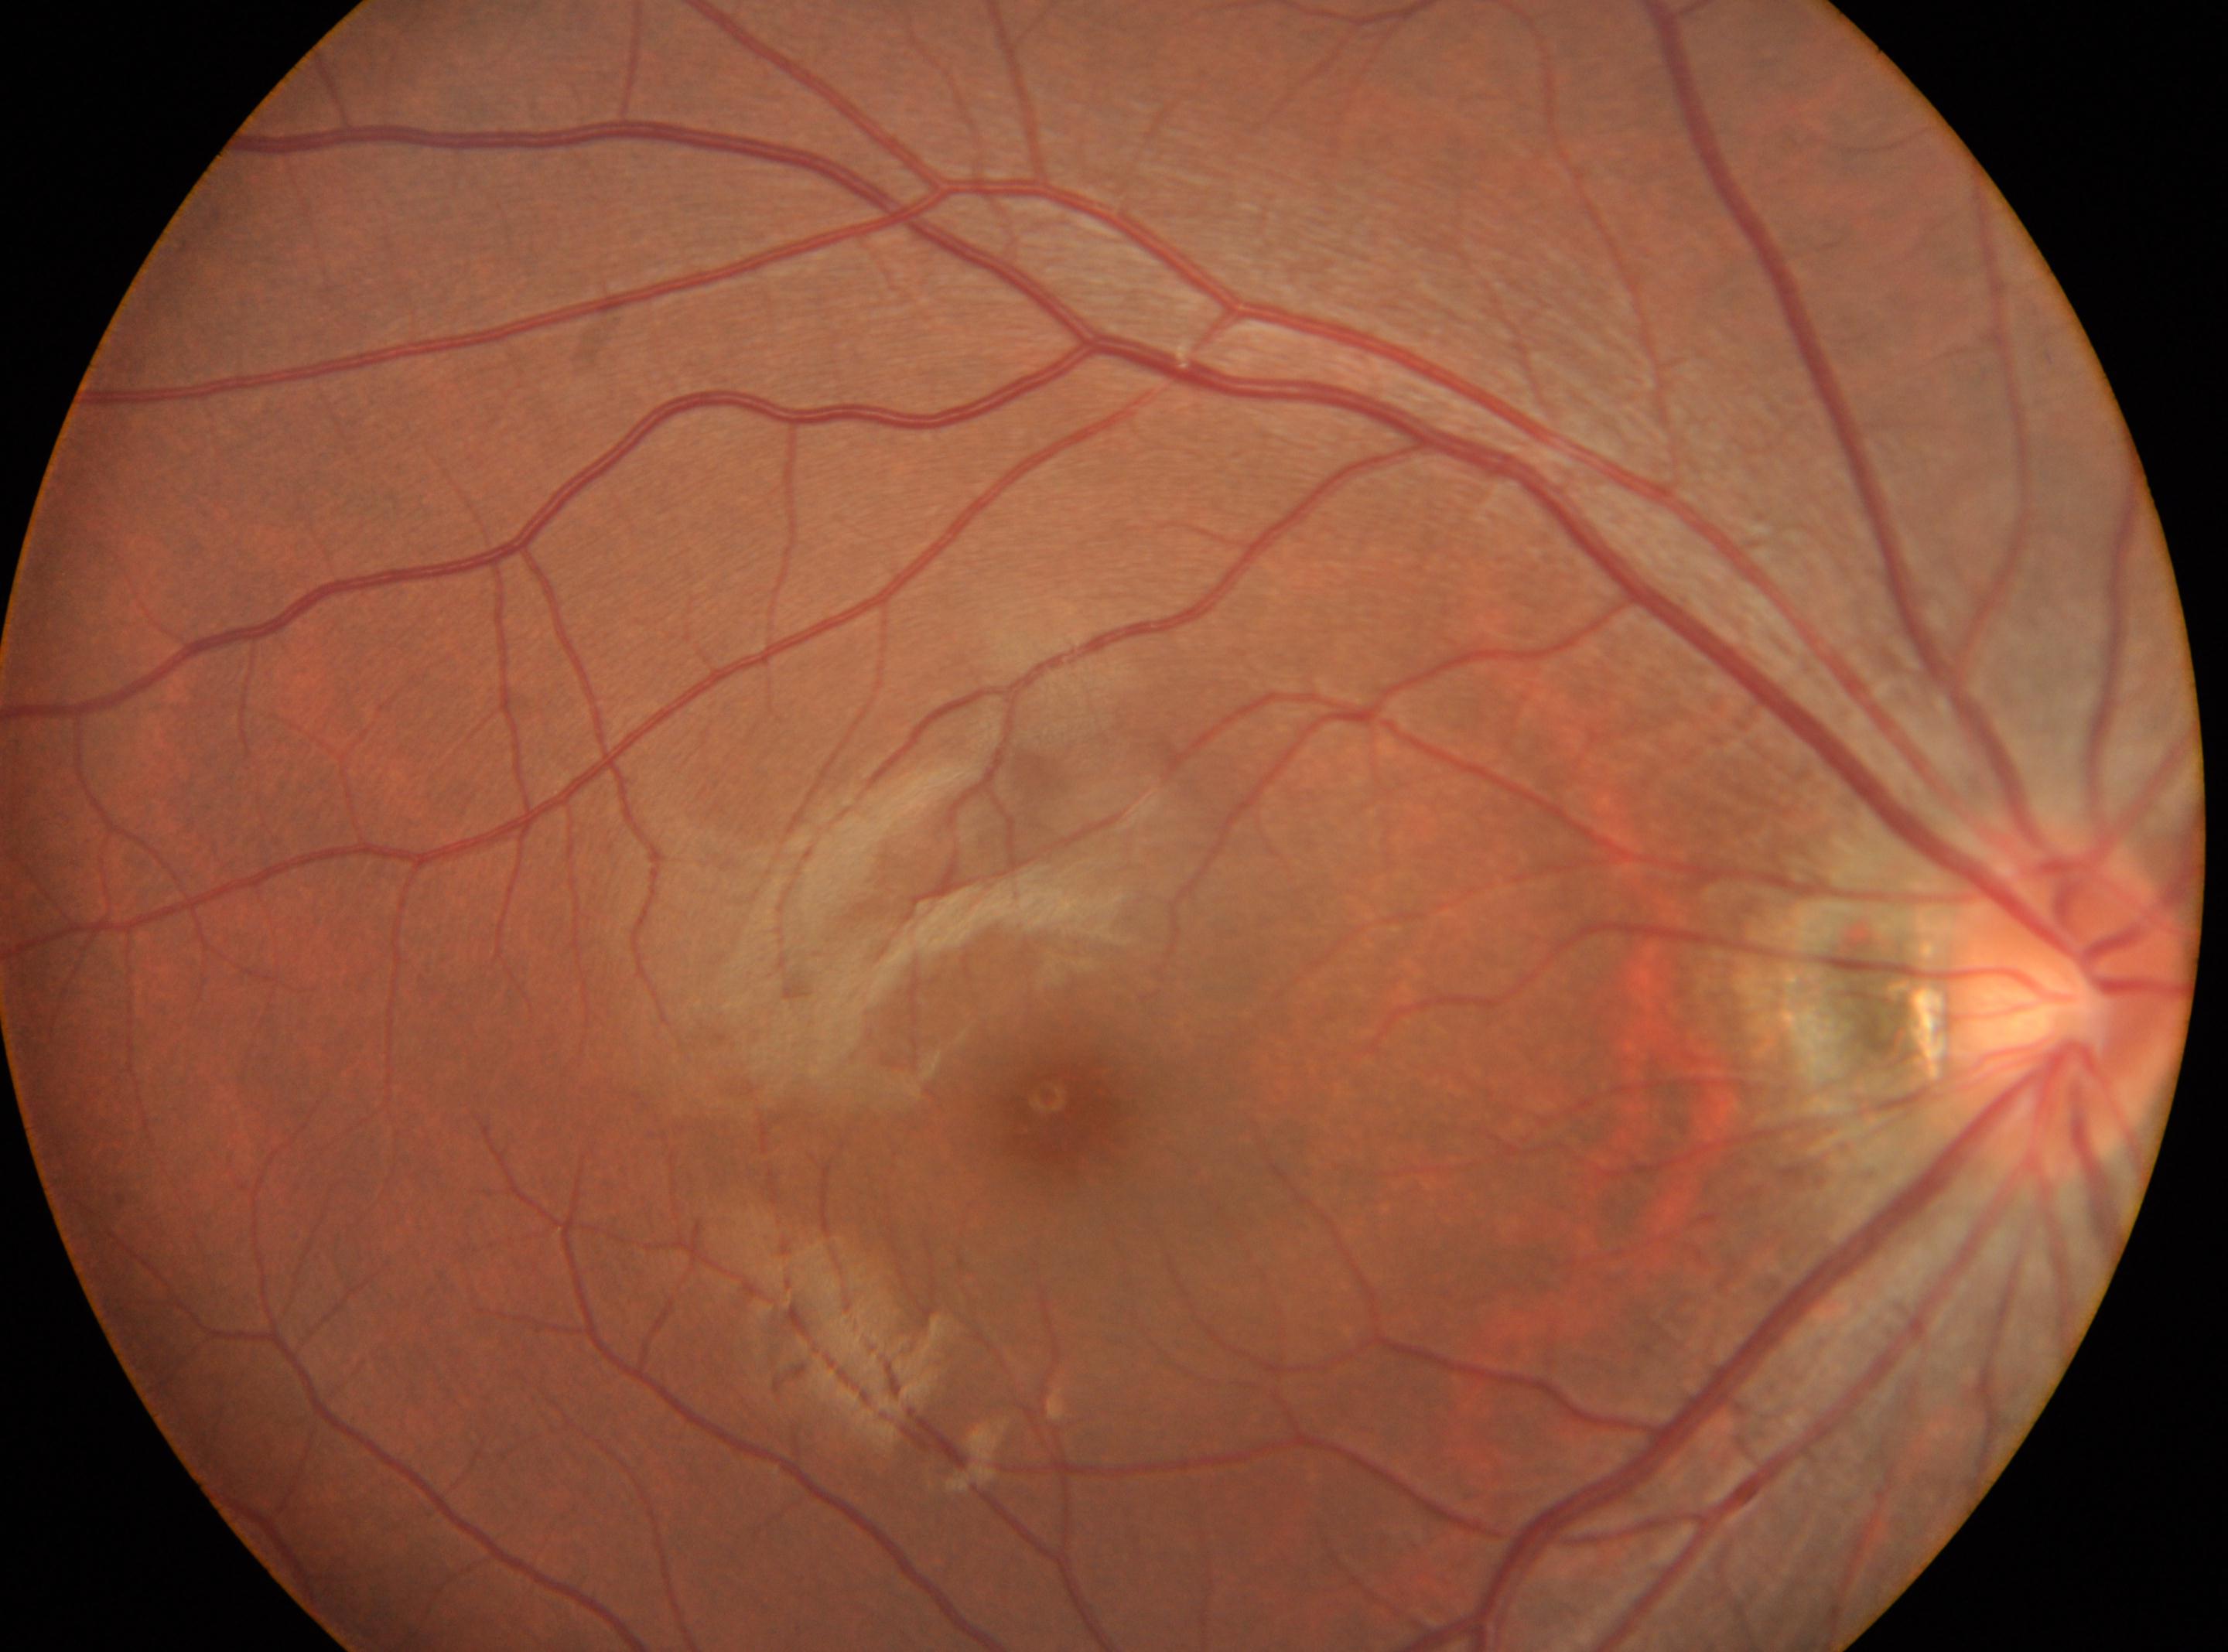 the fovea: x=1064, y=1114; ONH: x=2067, y=1002; DR: no apparent retinopathy (grade 0); laterality: right.